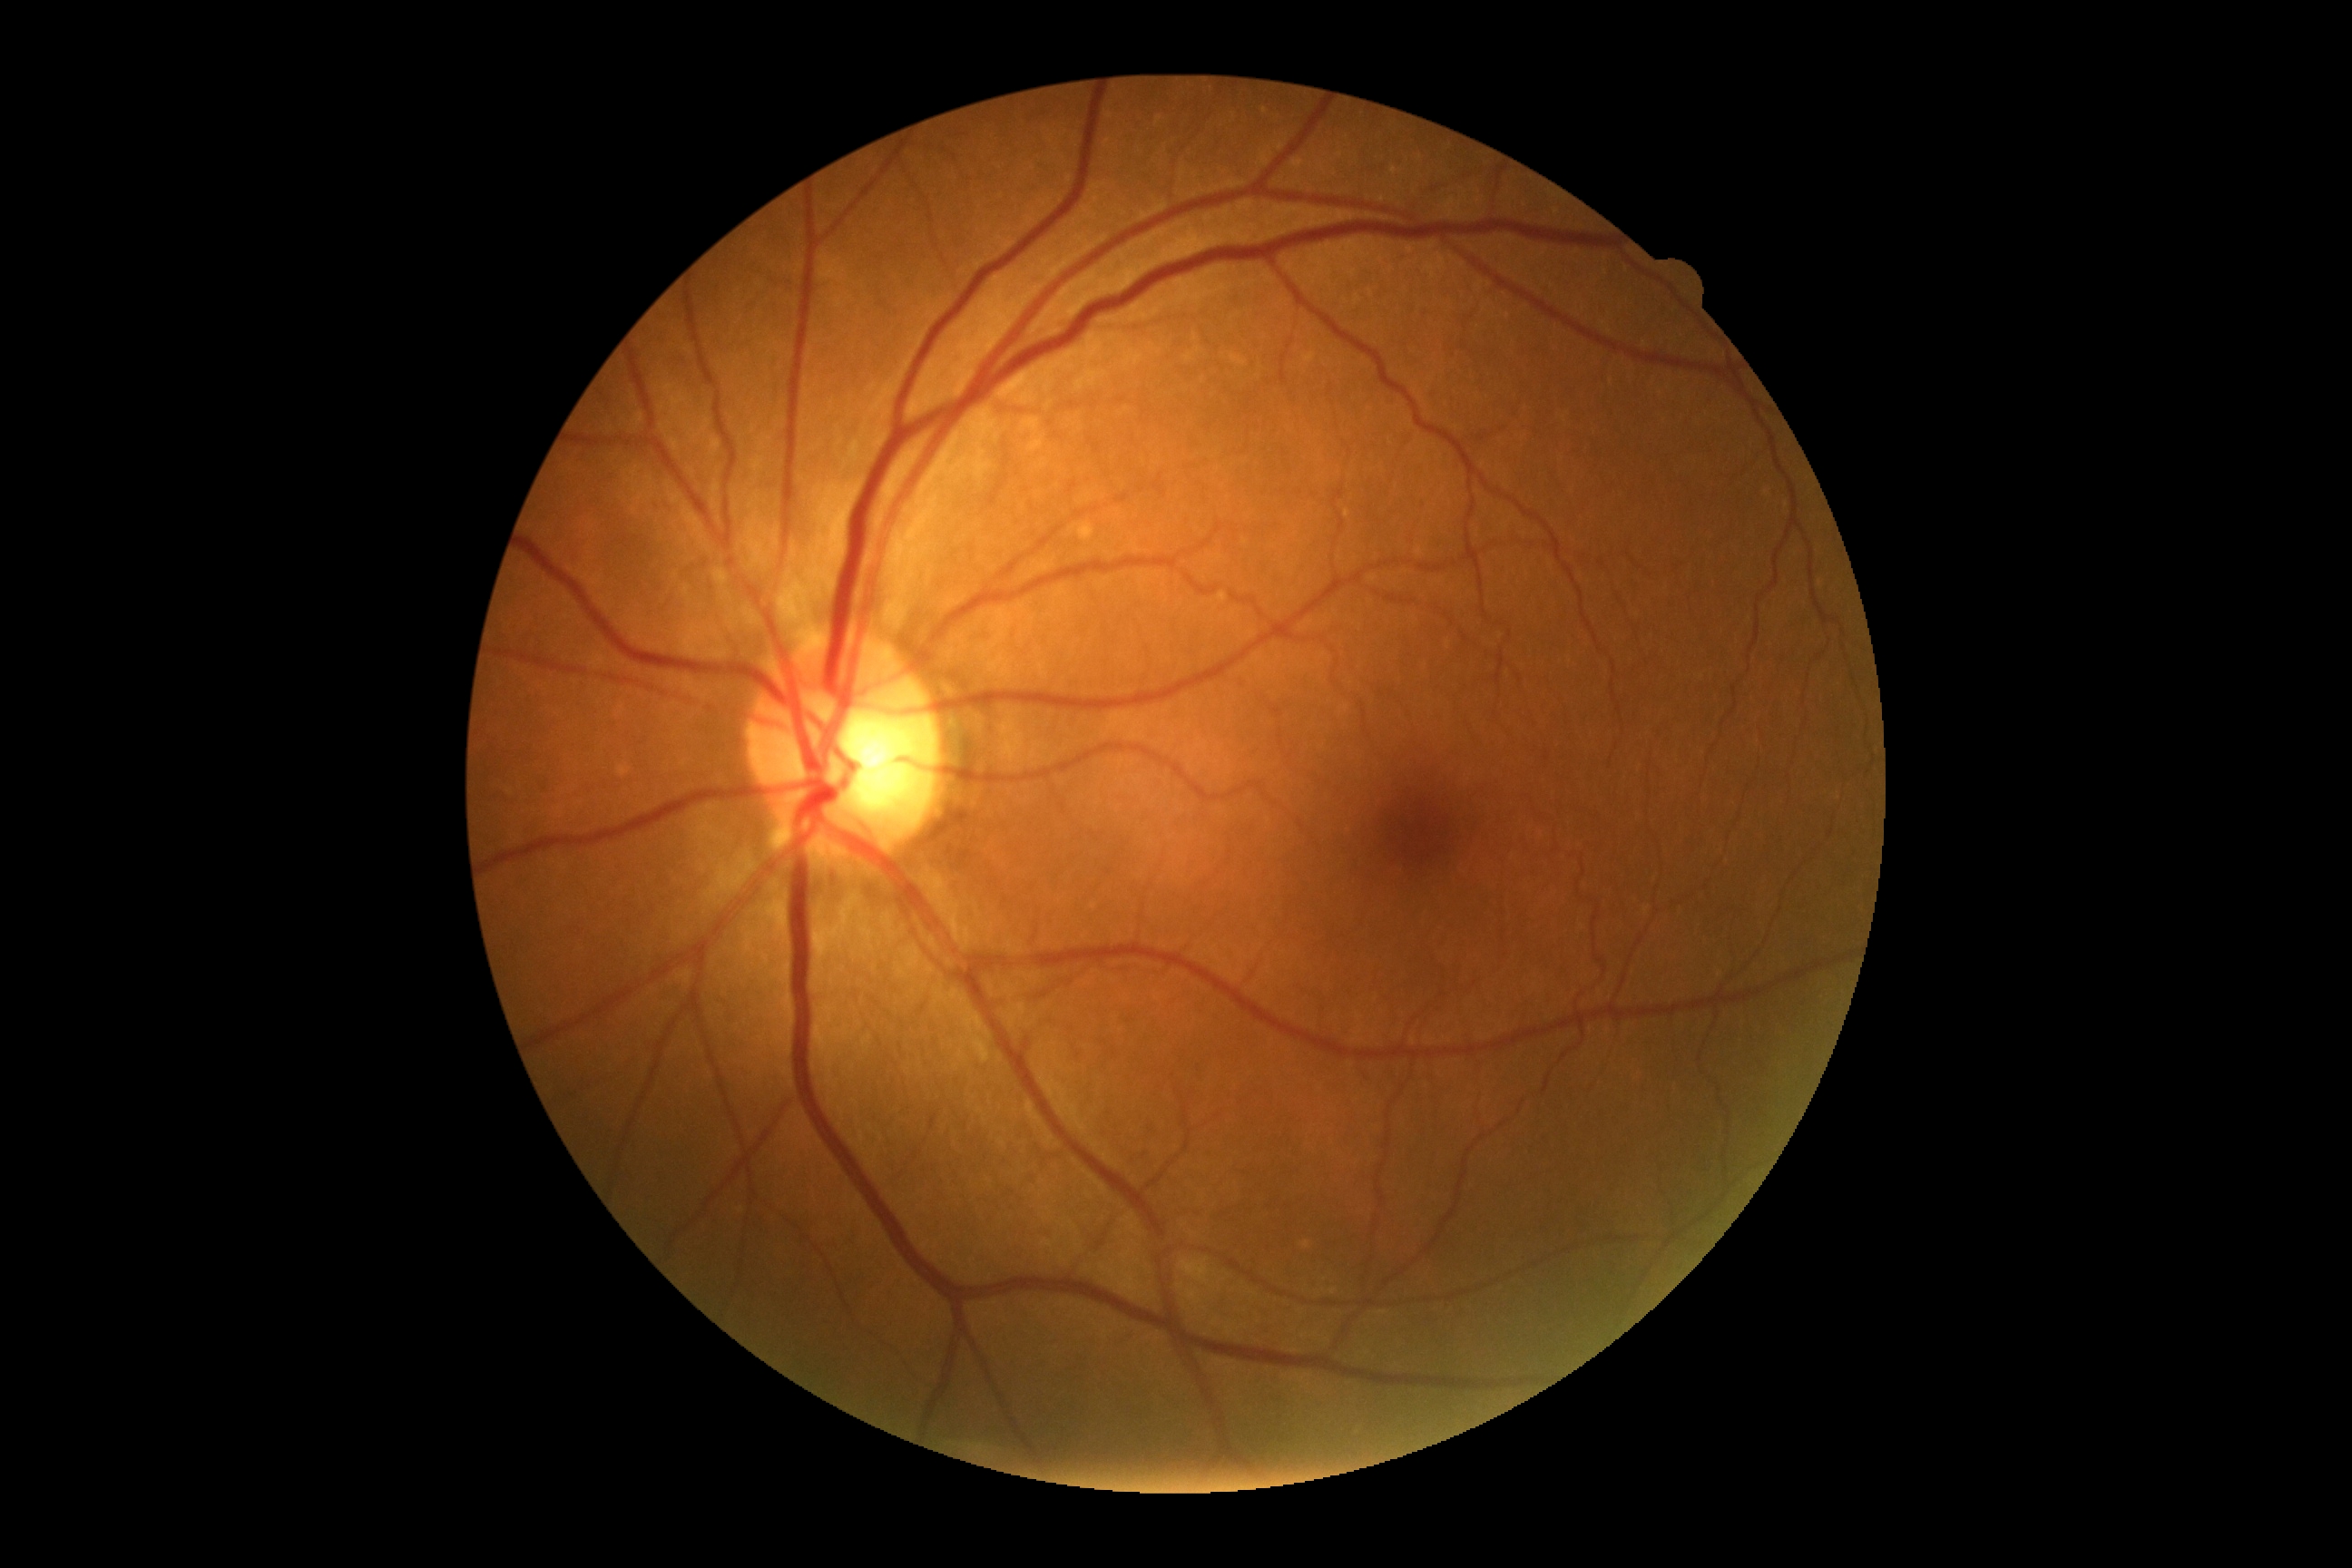 DR impression: no signs of DR, retinopathy: 0/4.